45-degree field of view: 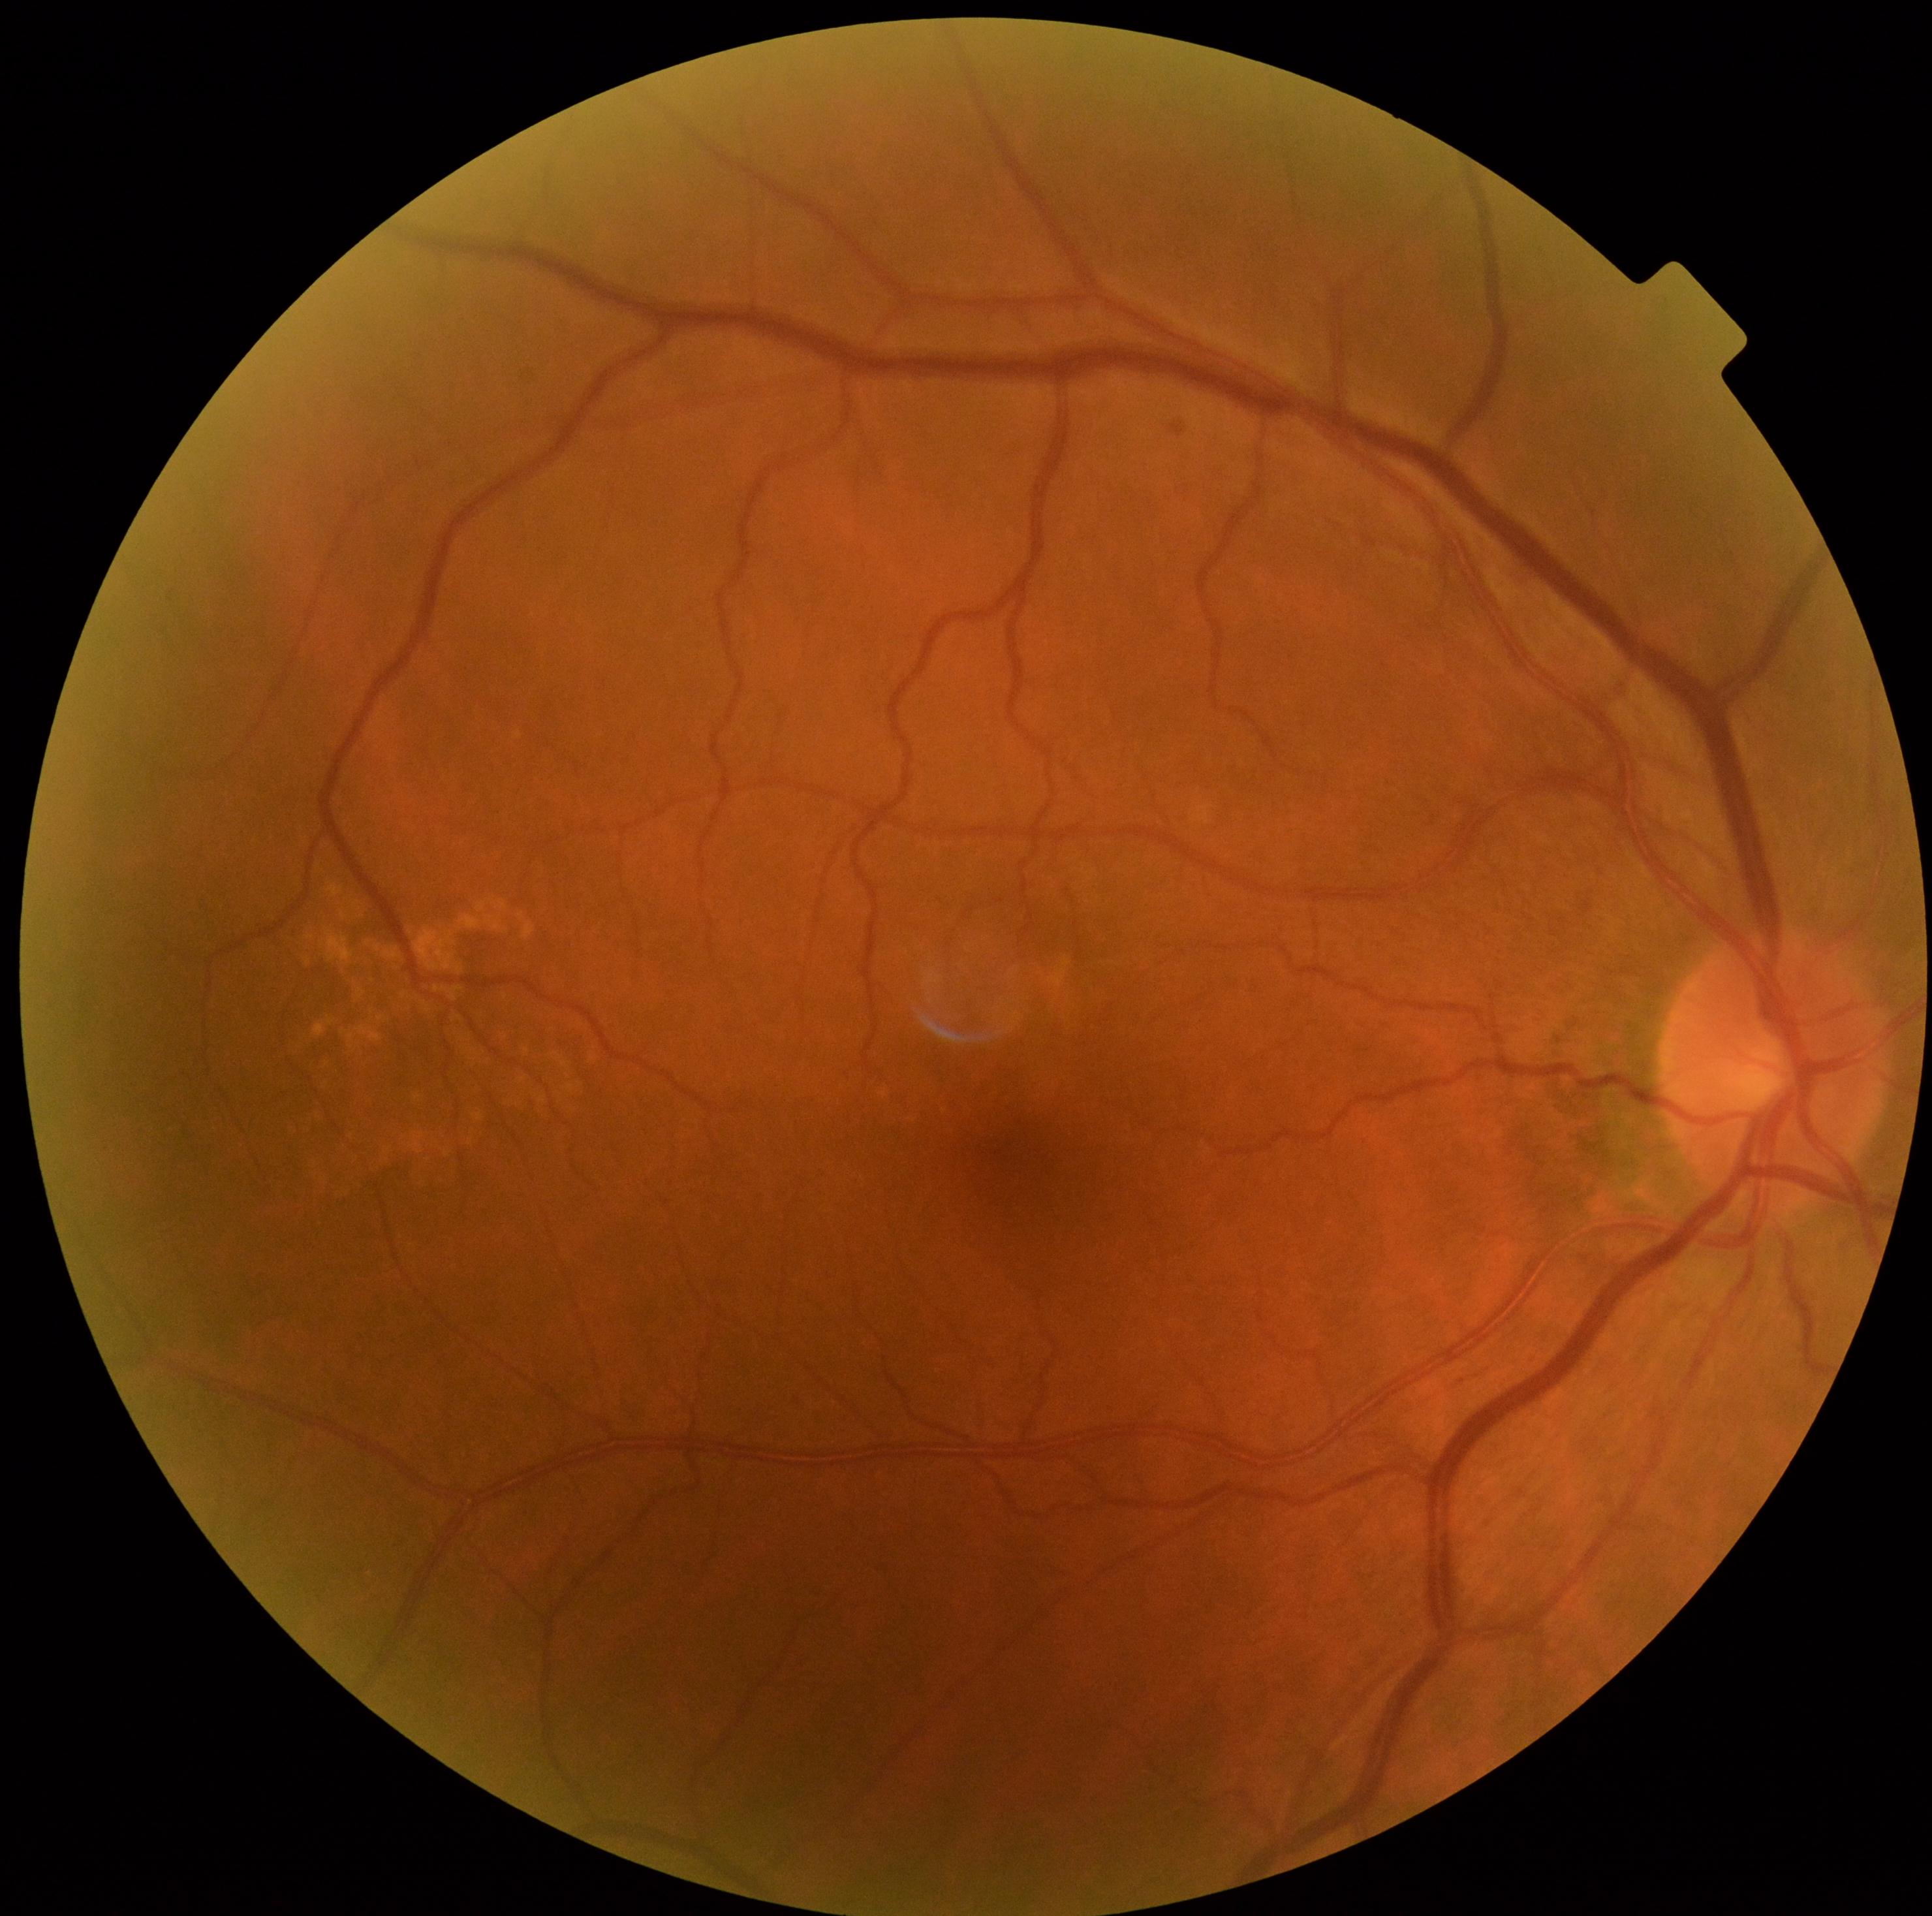   dr_impression: negative for DR
  dr_grade: 0